Image size 2352x1568 — 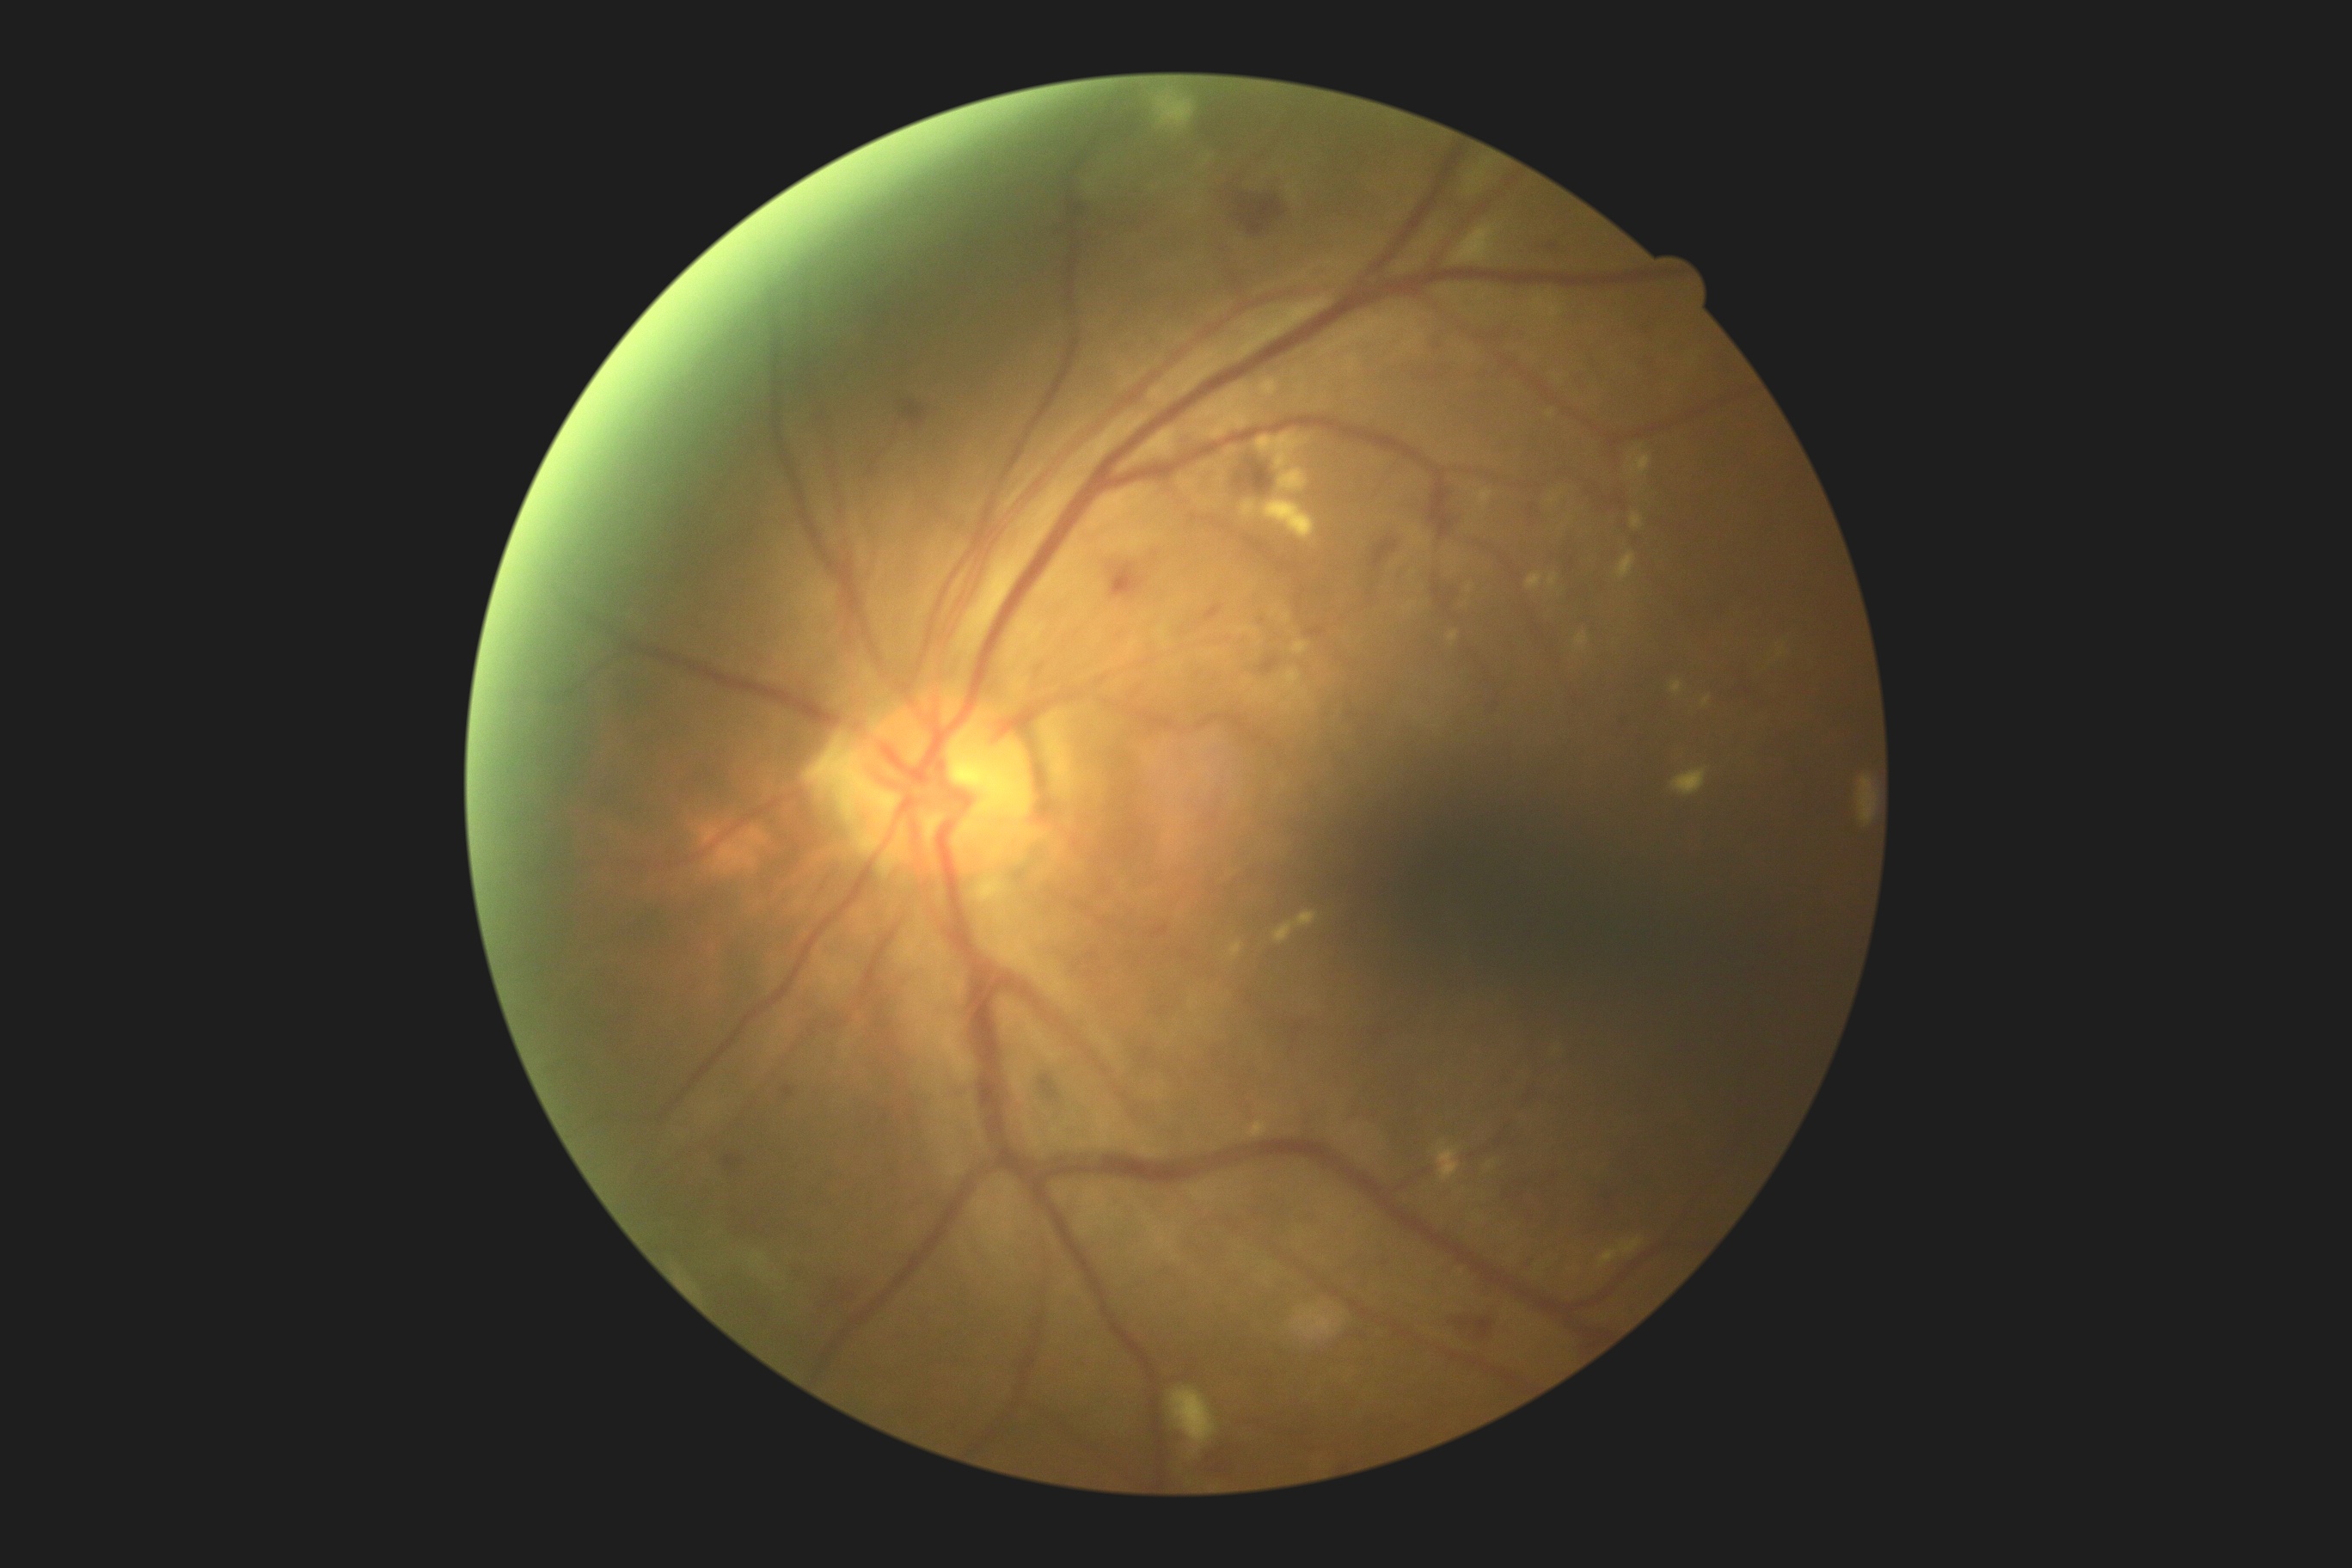
dr_grade: 2/4